Diabetic retinopathy graded by the modified Davis classification · nonmydriatic · posterior pole photograph.
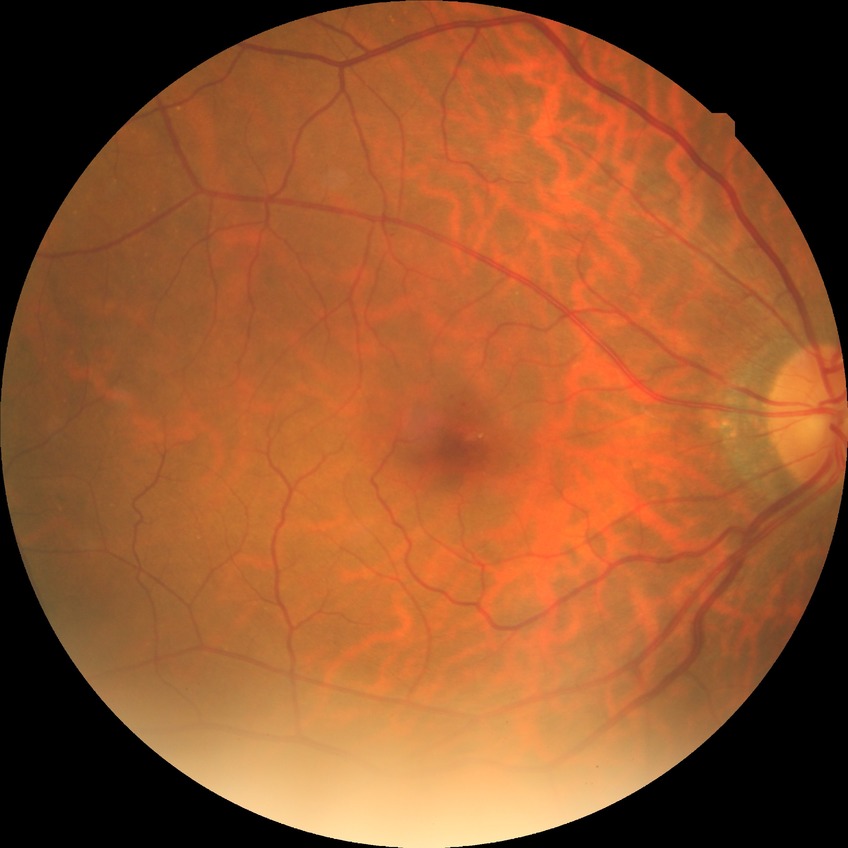

diabetic retinopathy stage = simple diabetic retinopathy